45° field of view: 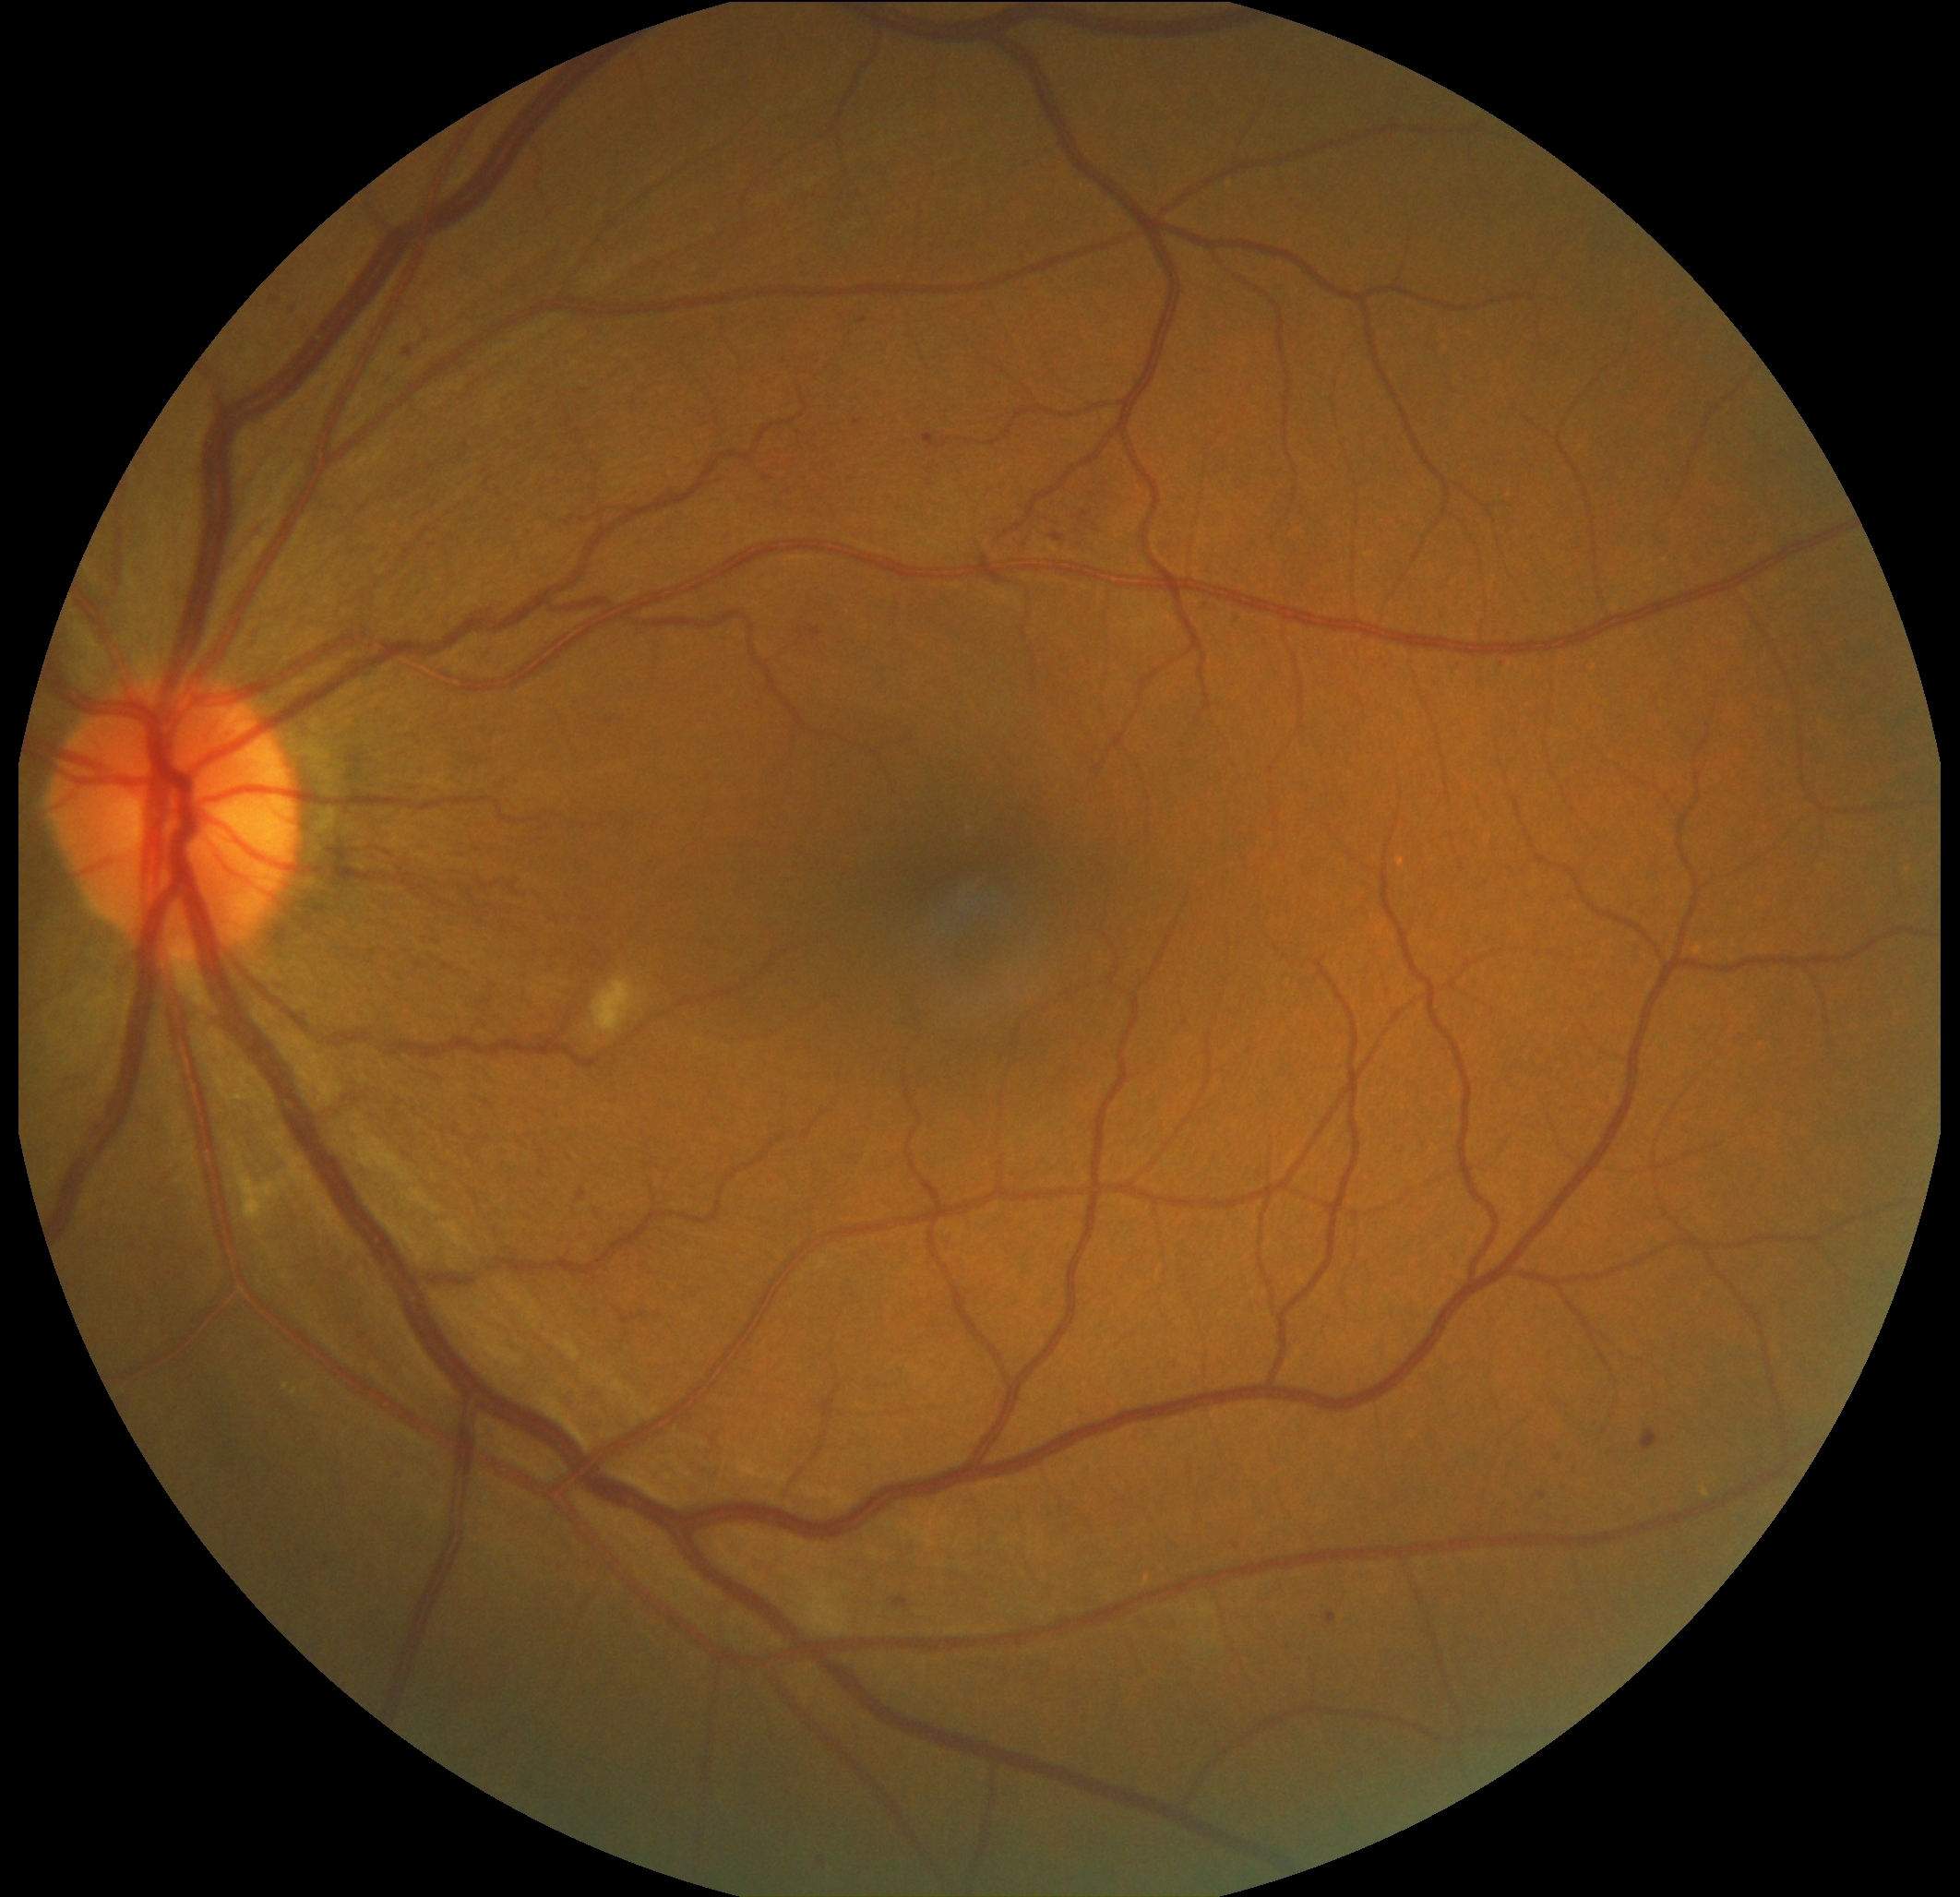 Diabetic retinopathy grade is 2/4 — more than just microaneurysms but less than severe NPDR.